2352 by 1568 pixels.
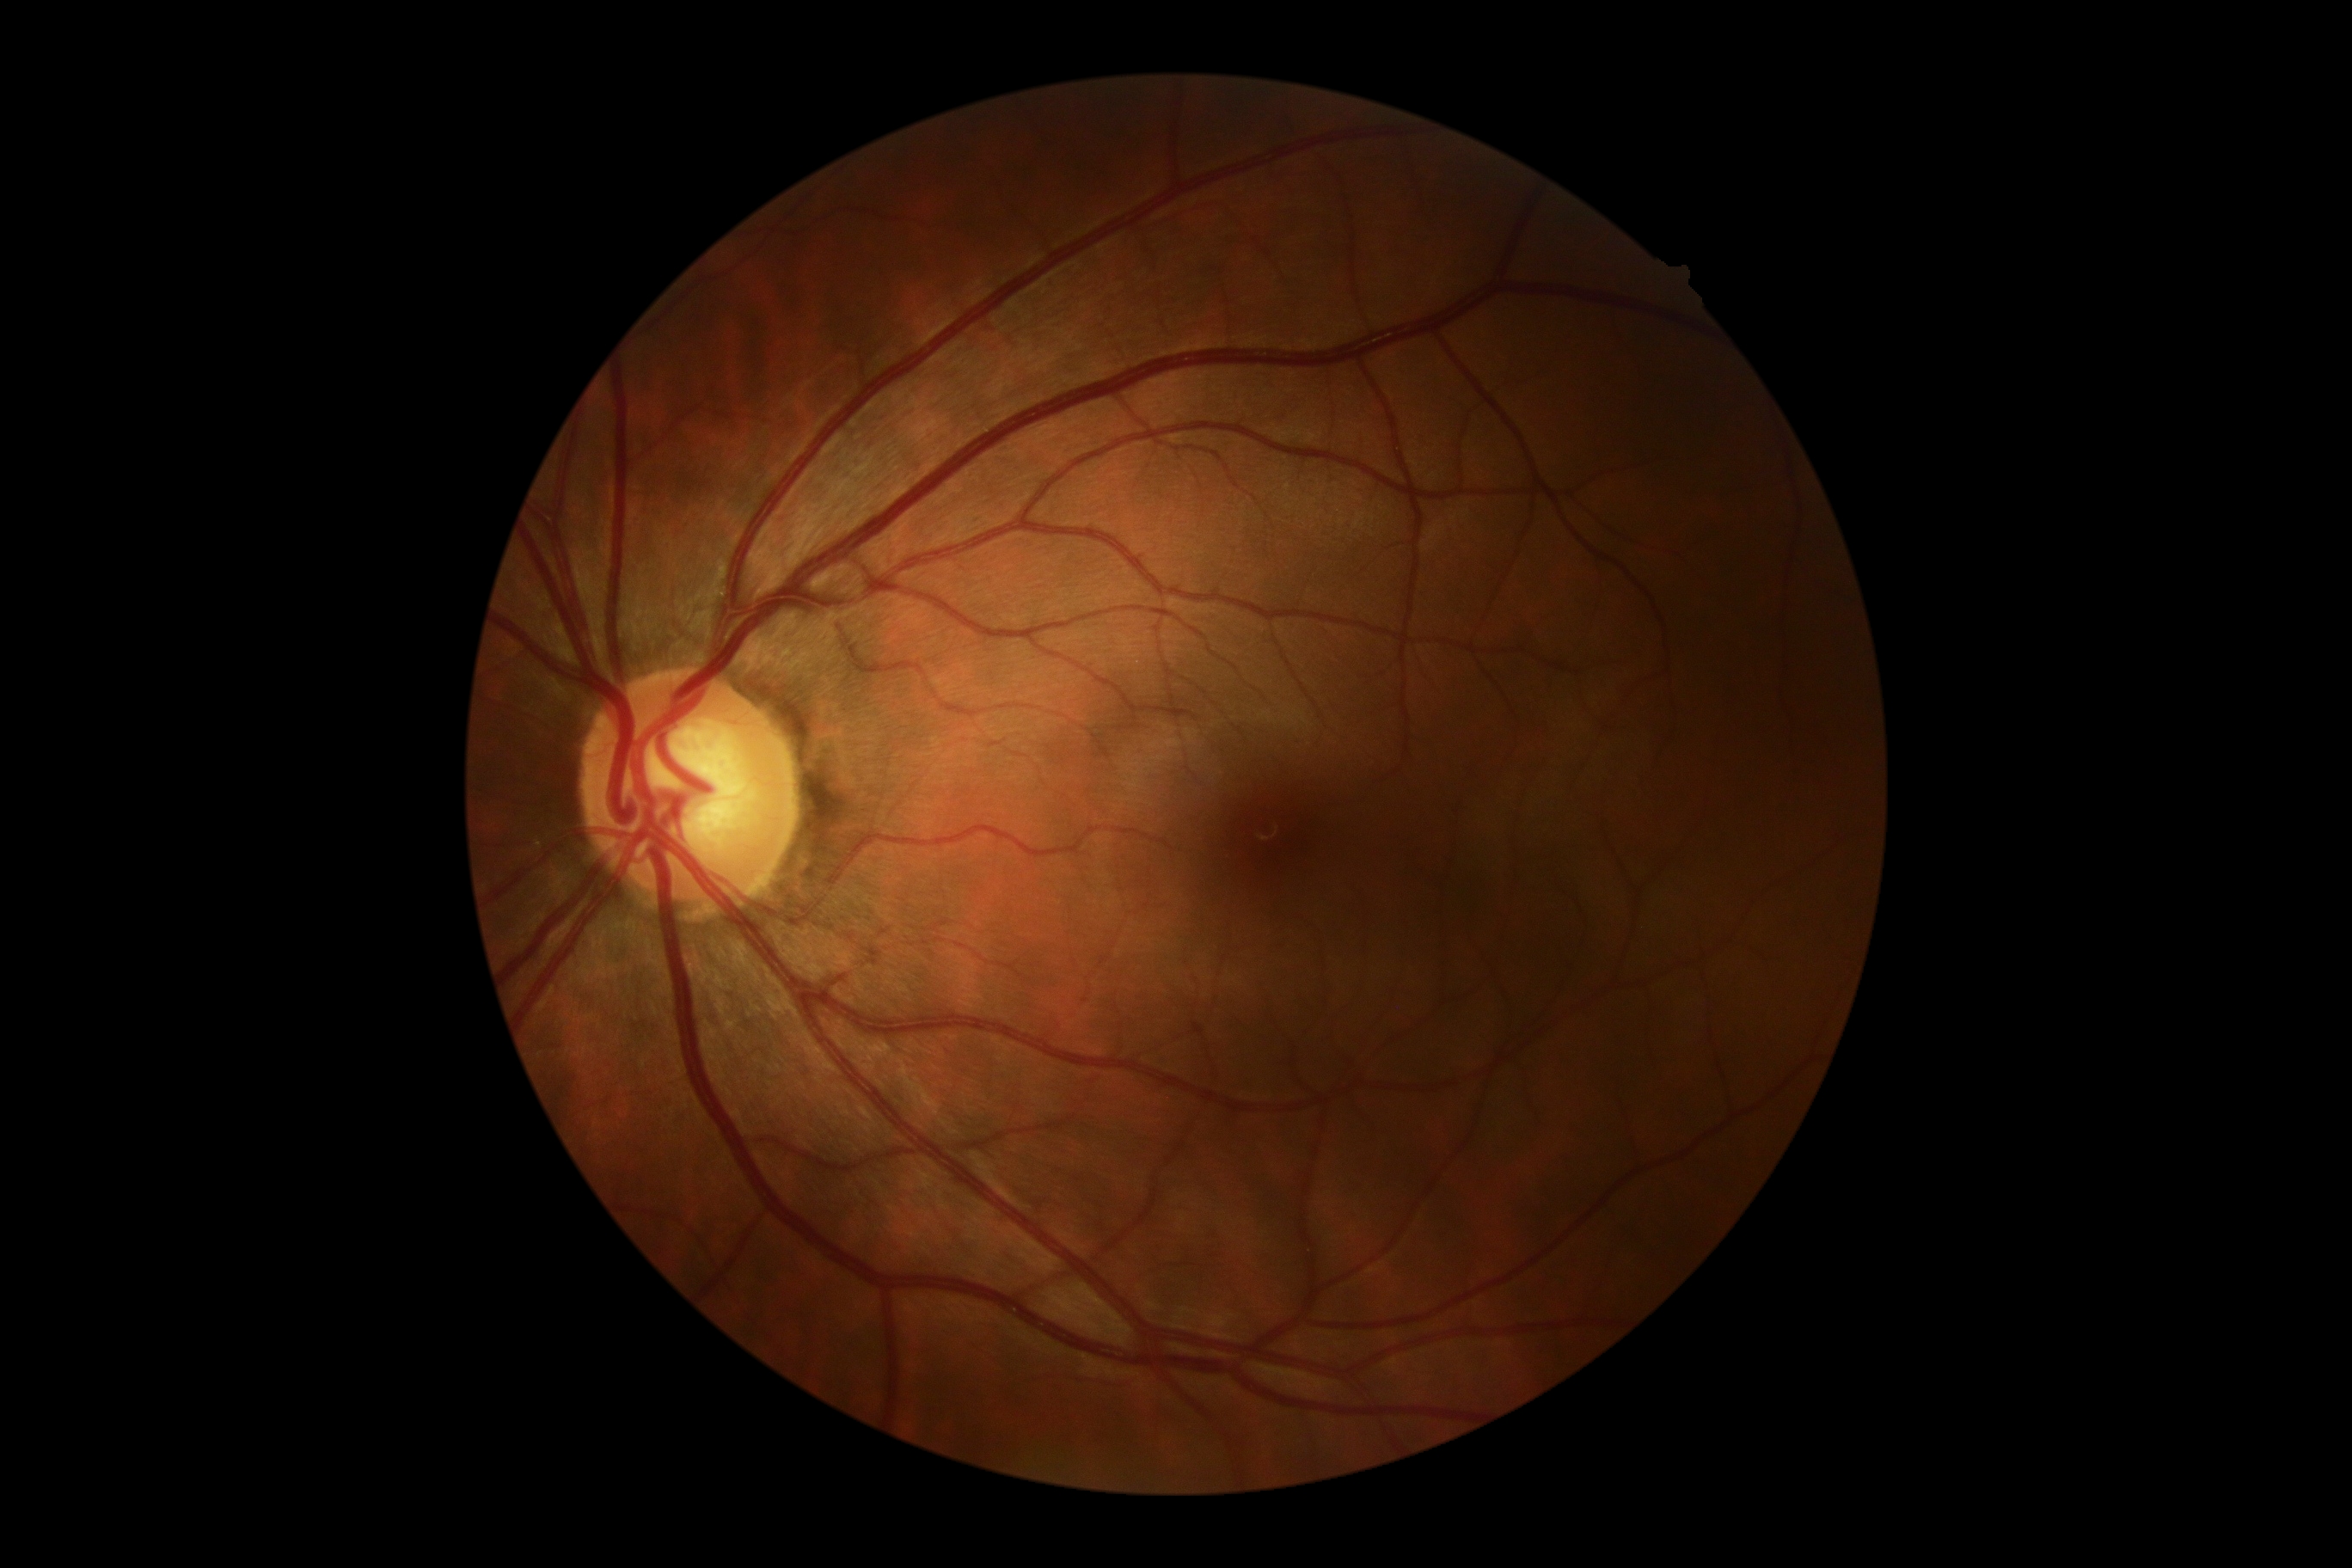 DR stage is grade 0 (no apparent retinopathy).